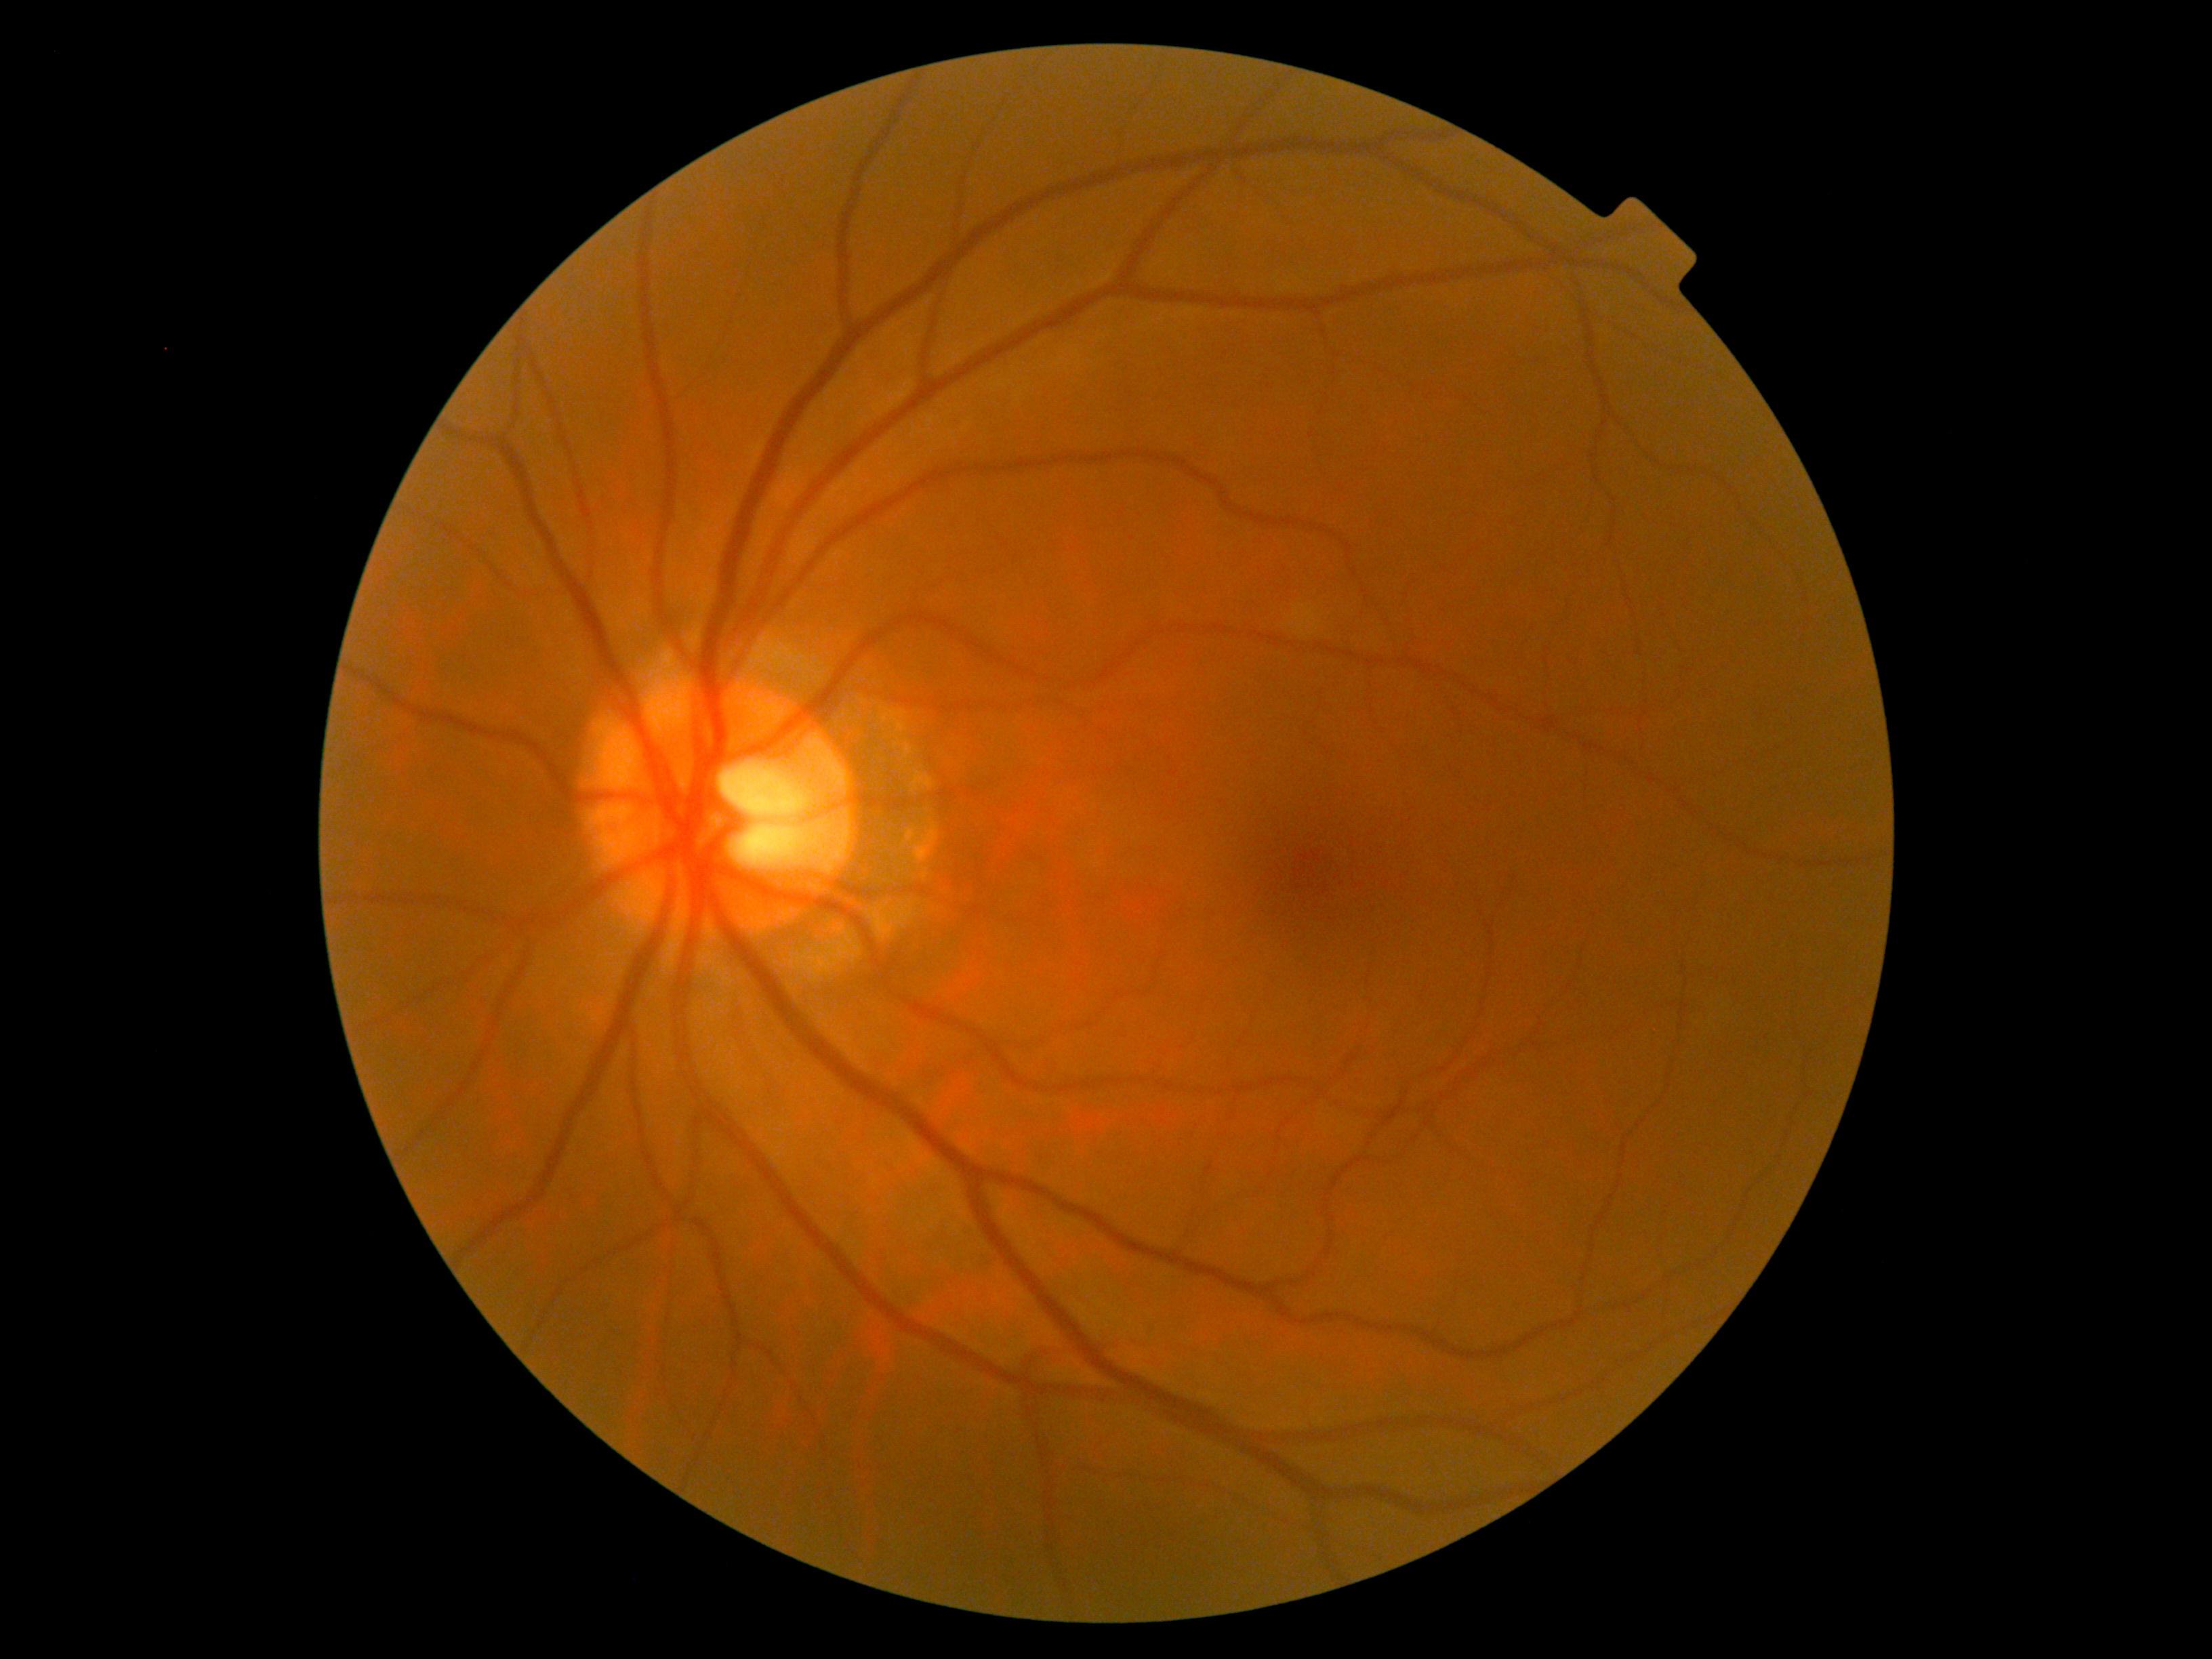
Retinopathy is no apparent retinopathy (grade 0).